Wide-field contact fundus photograph of an infant: 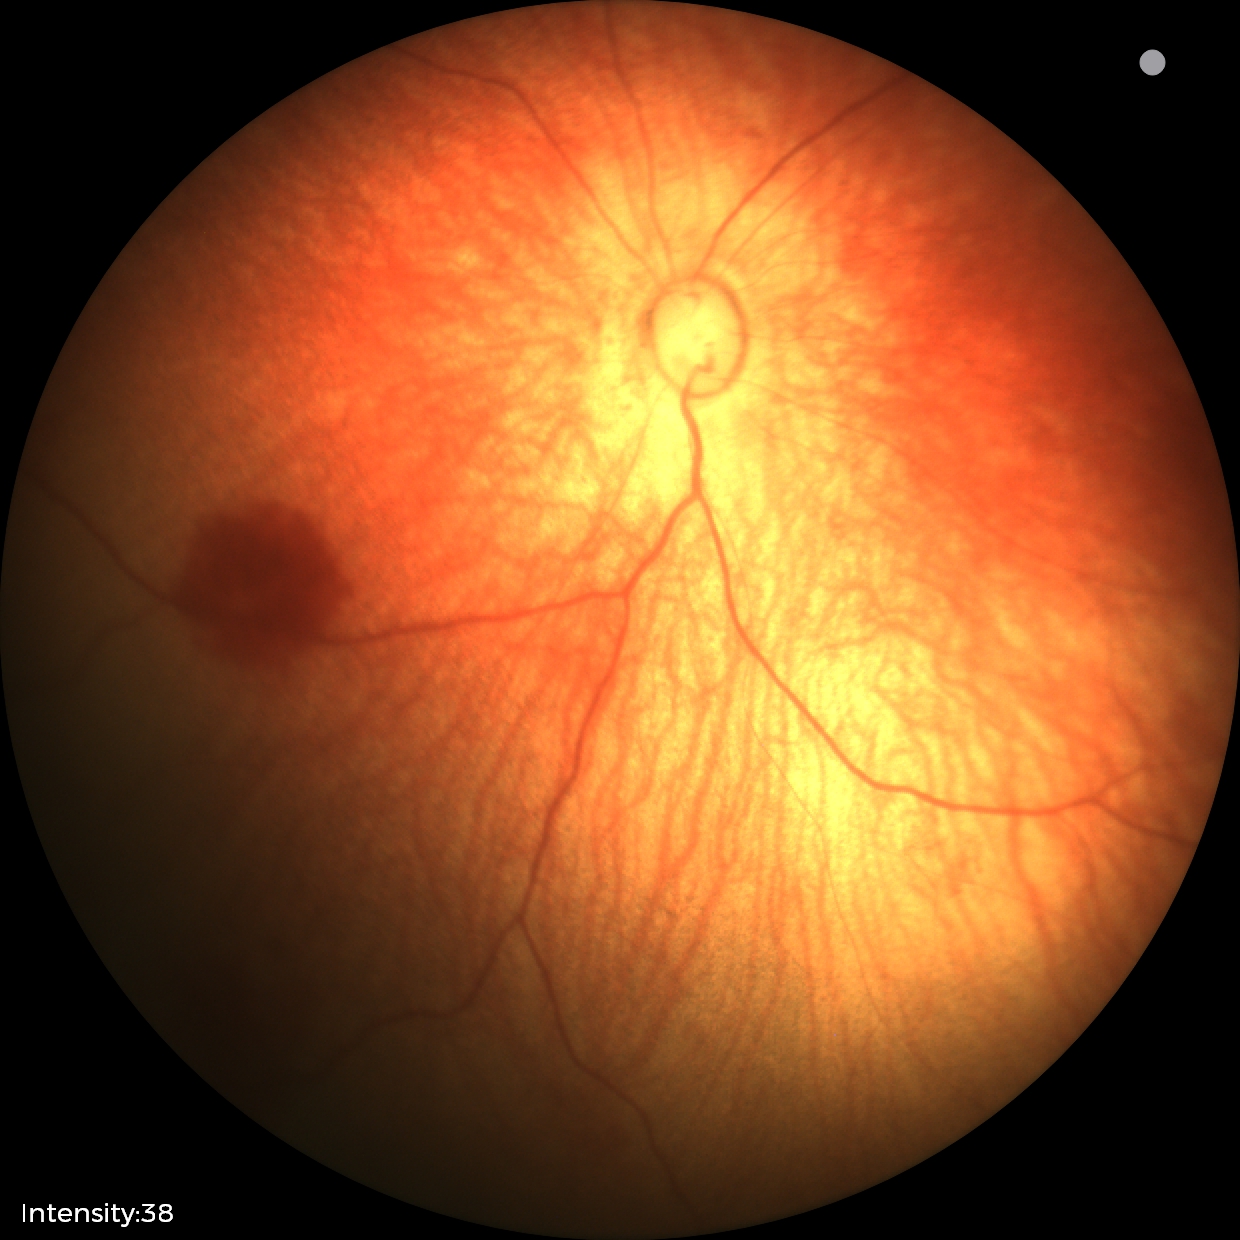 Screening examination diagnosed as physiological.